Color fundus photograph:
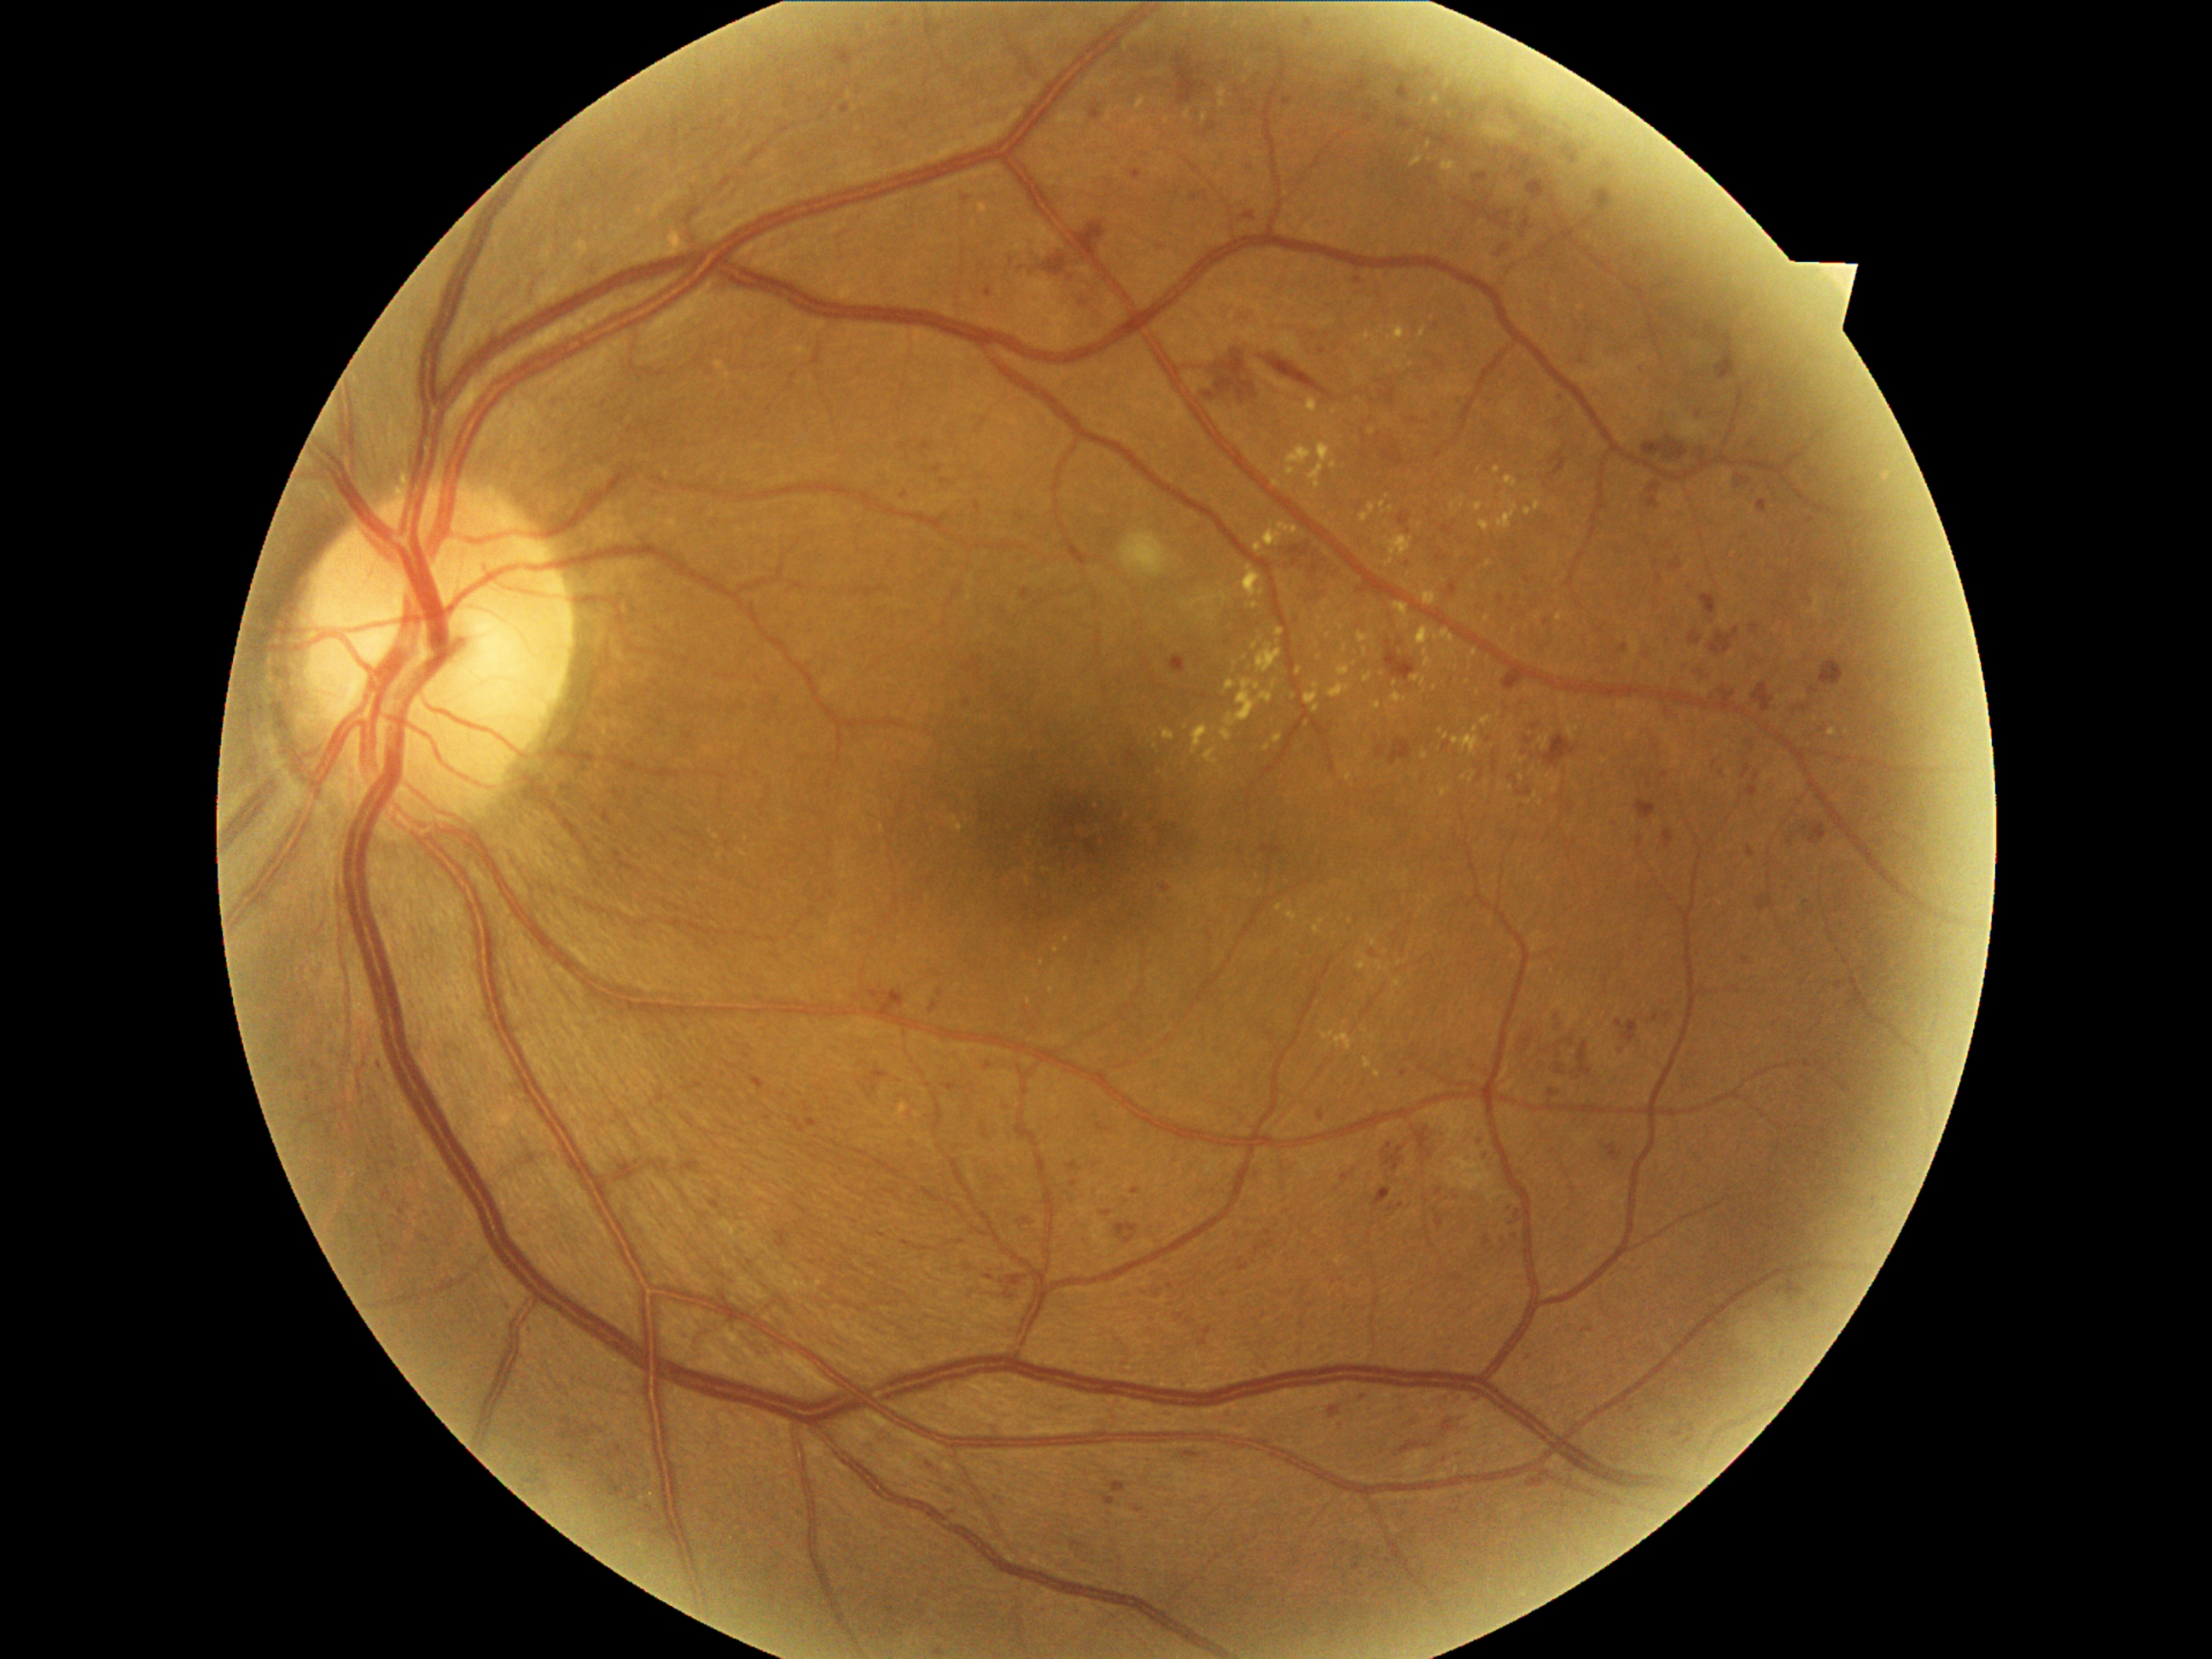
DR severity: 3.